45° FOV. 848x848px. Diabetic retinopathy graded by the modified Davis classification — 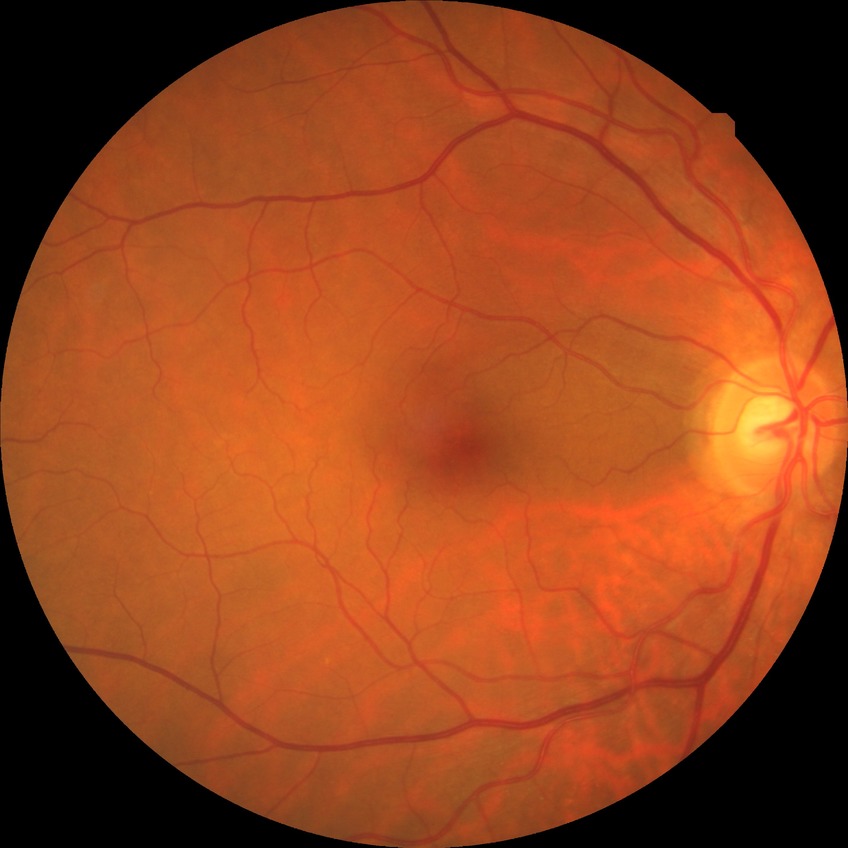

diabetic retinopathy (DR): no diabetic retinopathy (NDR).